Modified Davis grading. Image size 848x848. FOV: 45 degrees — 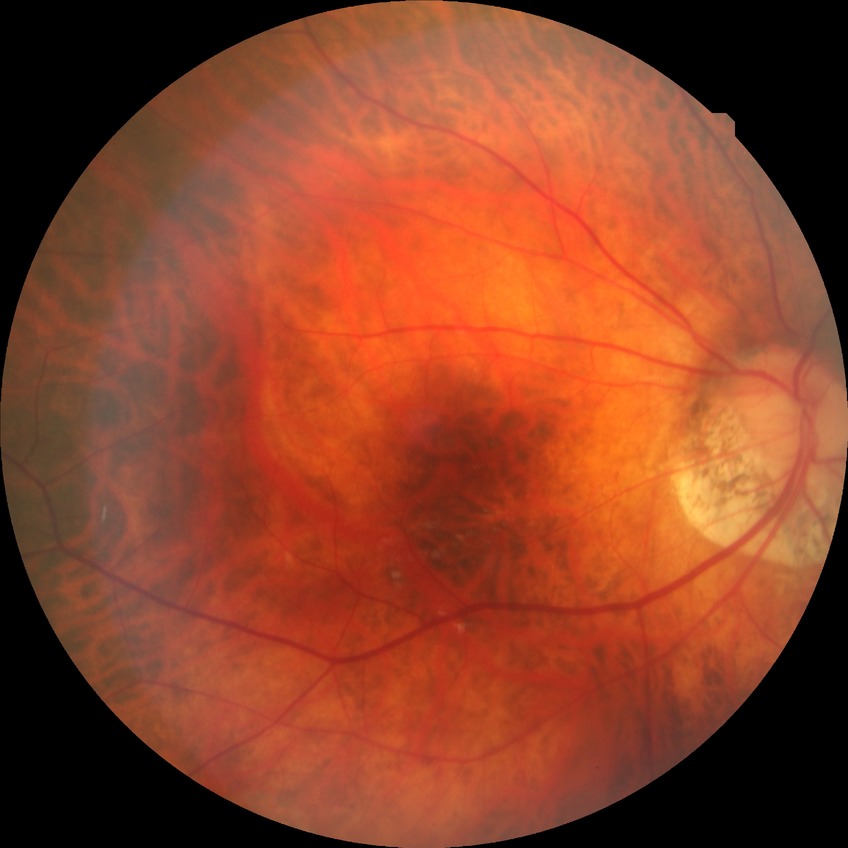
Retinopathy grade: no diabetic retinopathy.